2352 by 1568 pixels. Color fundus photograph:
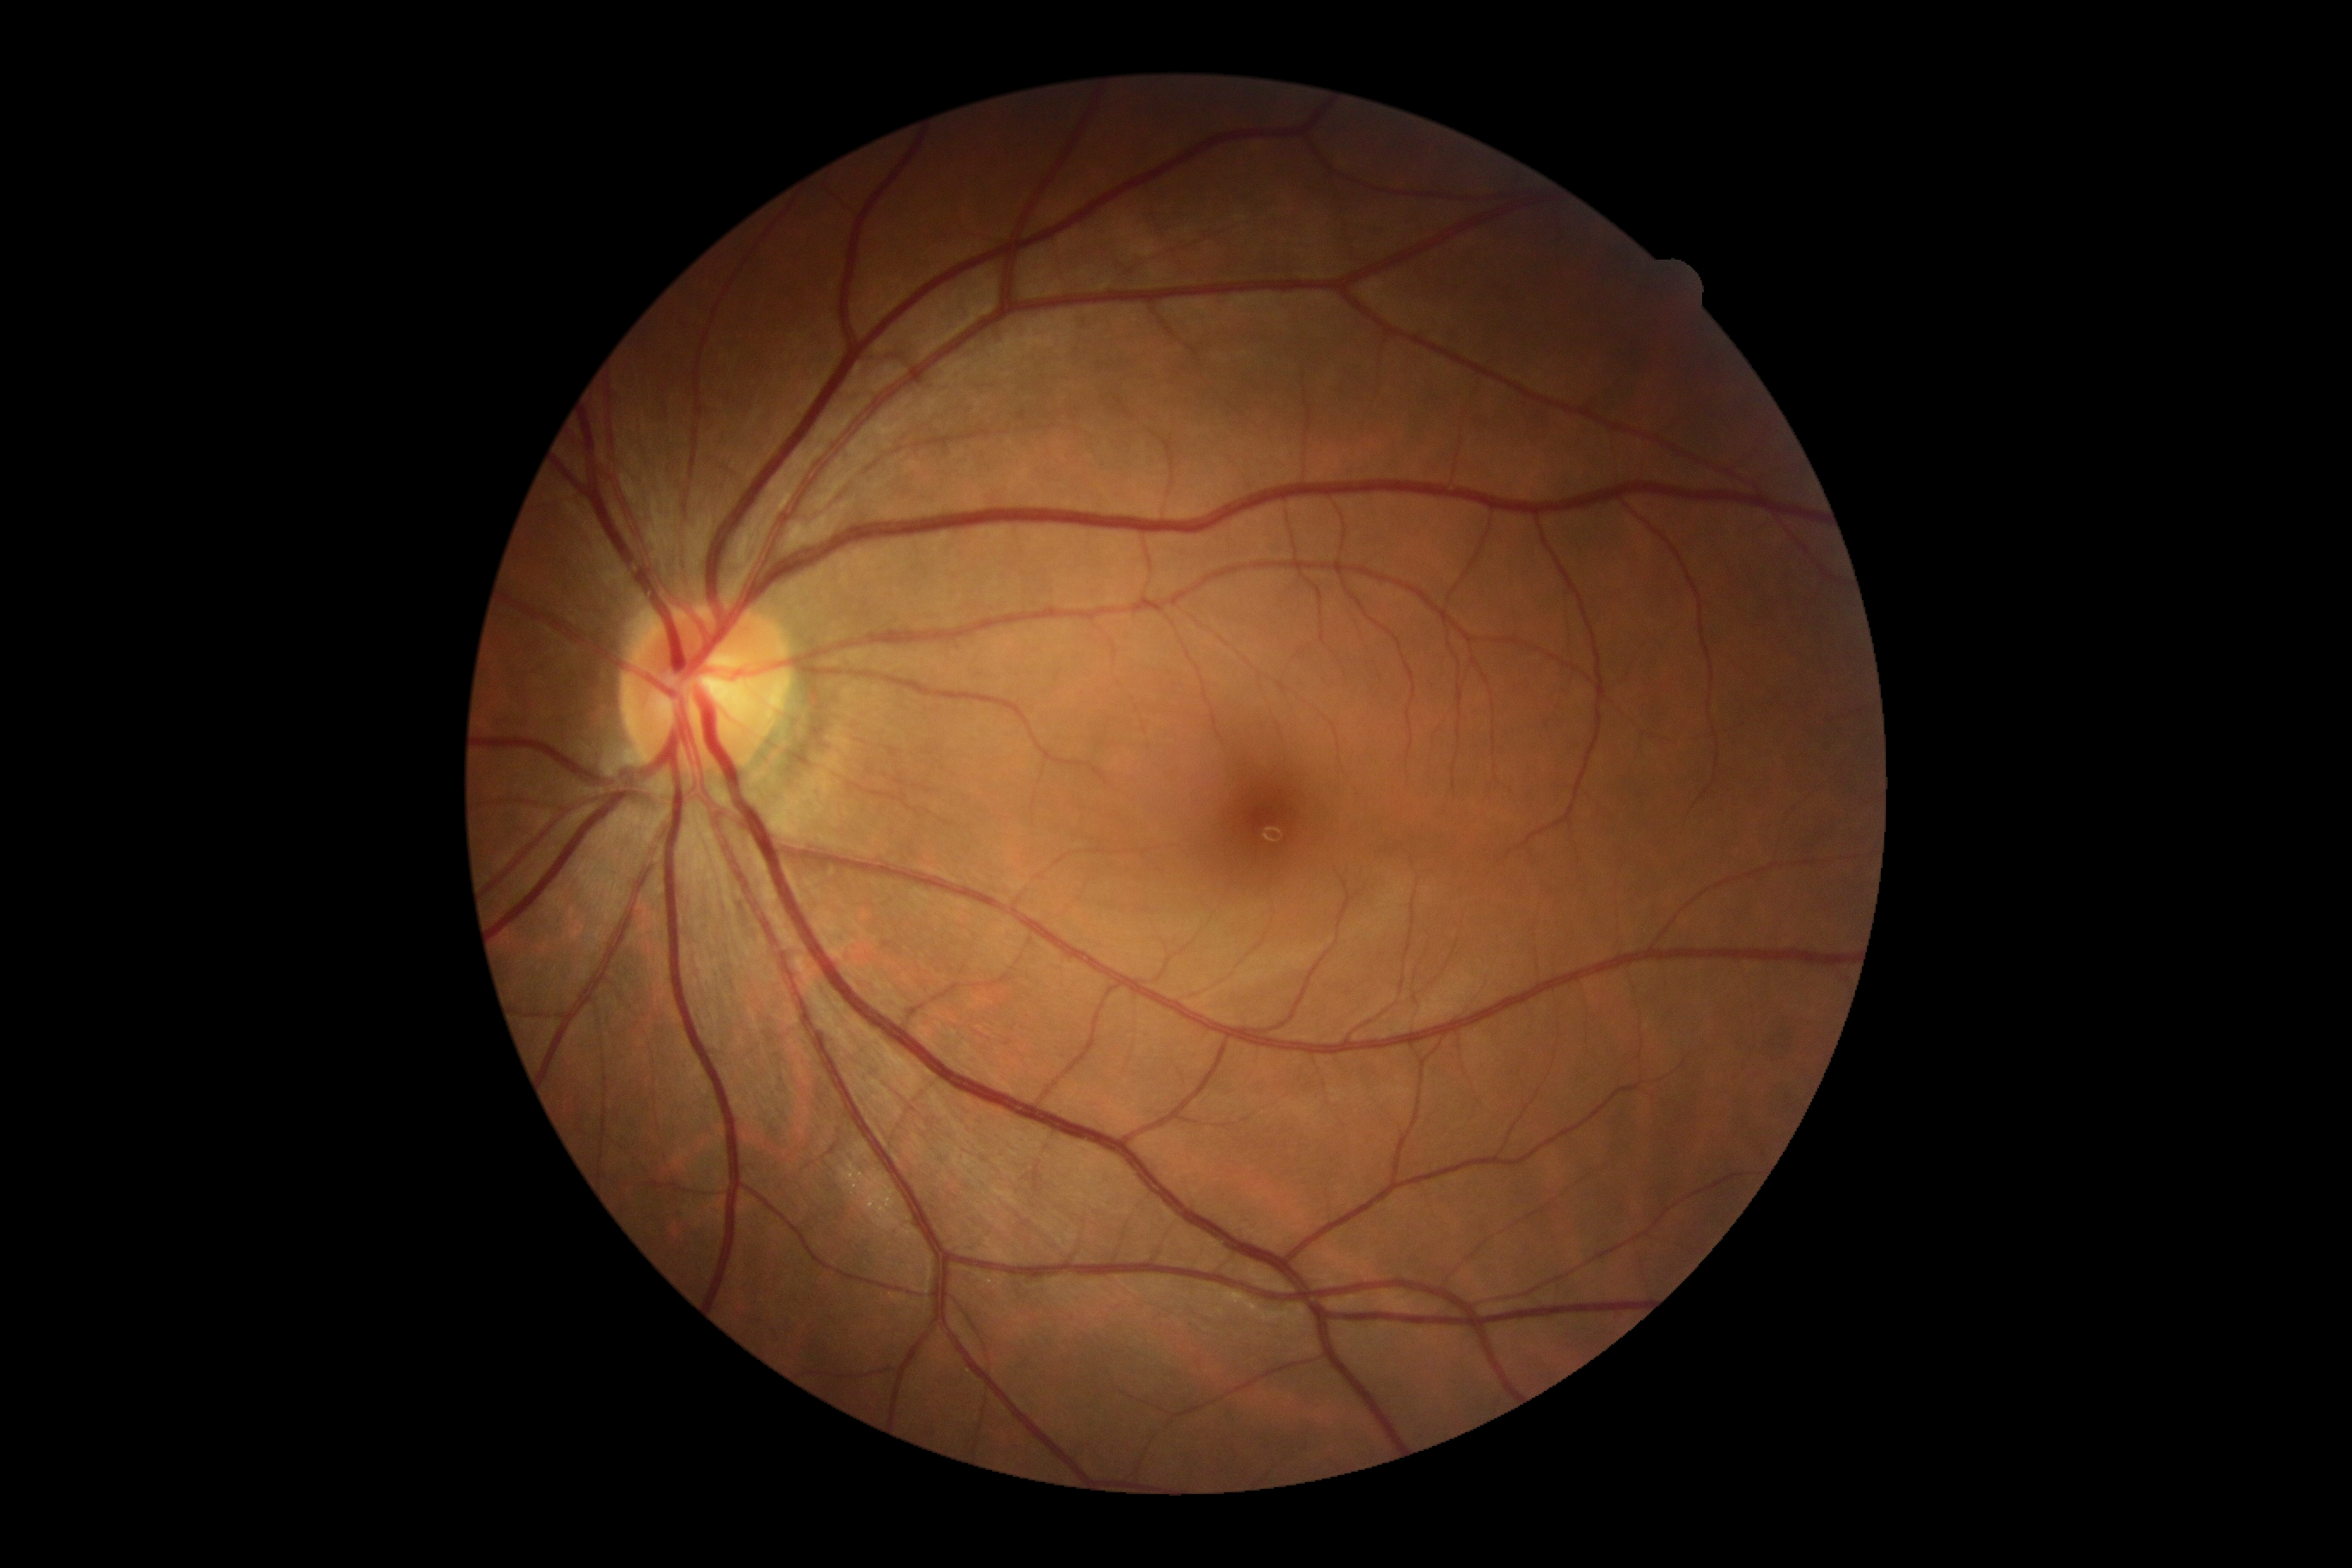 No signs of diabetic retinopathy. Diabetic retinopathy (DR): 0/4.